Color fundus photograph:
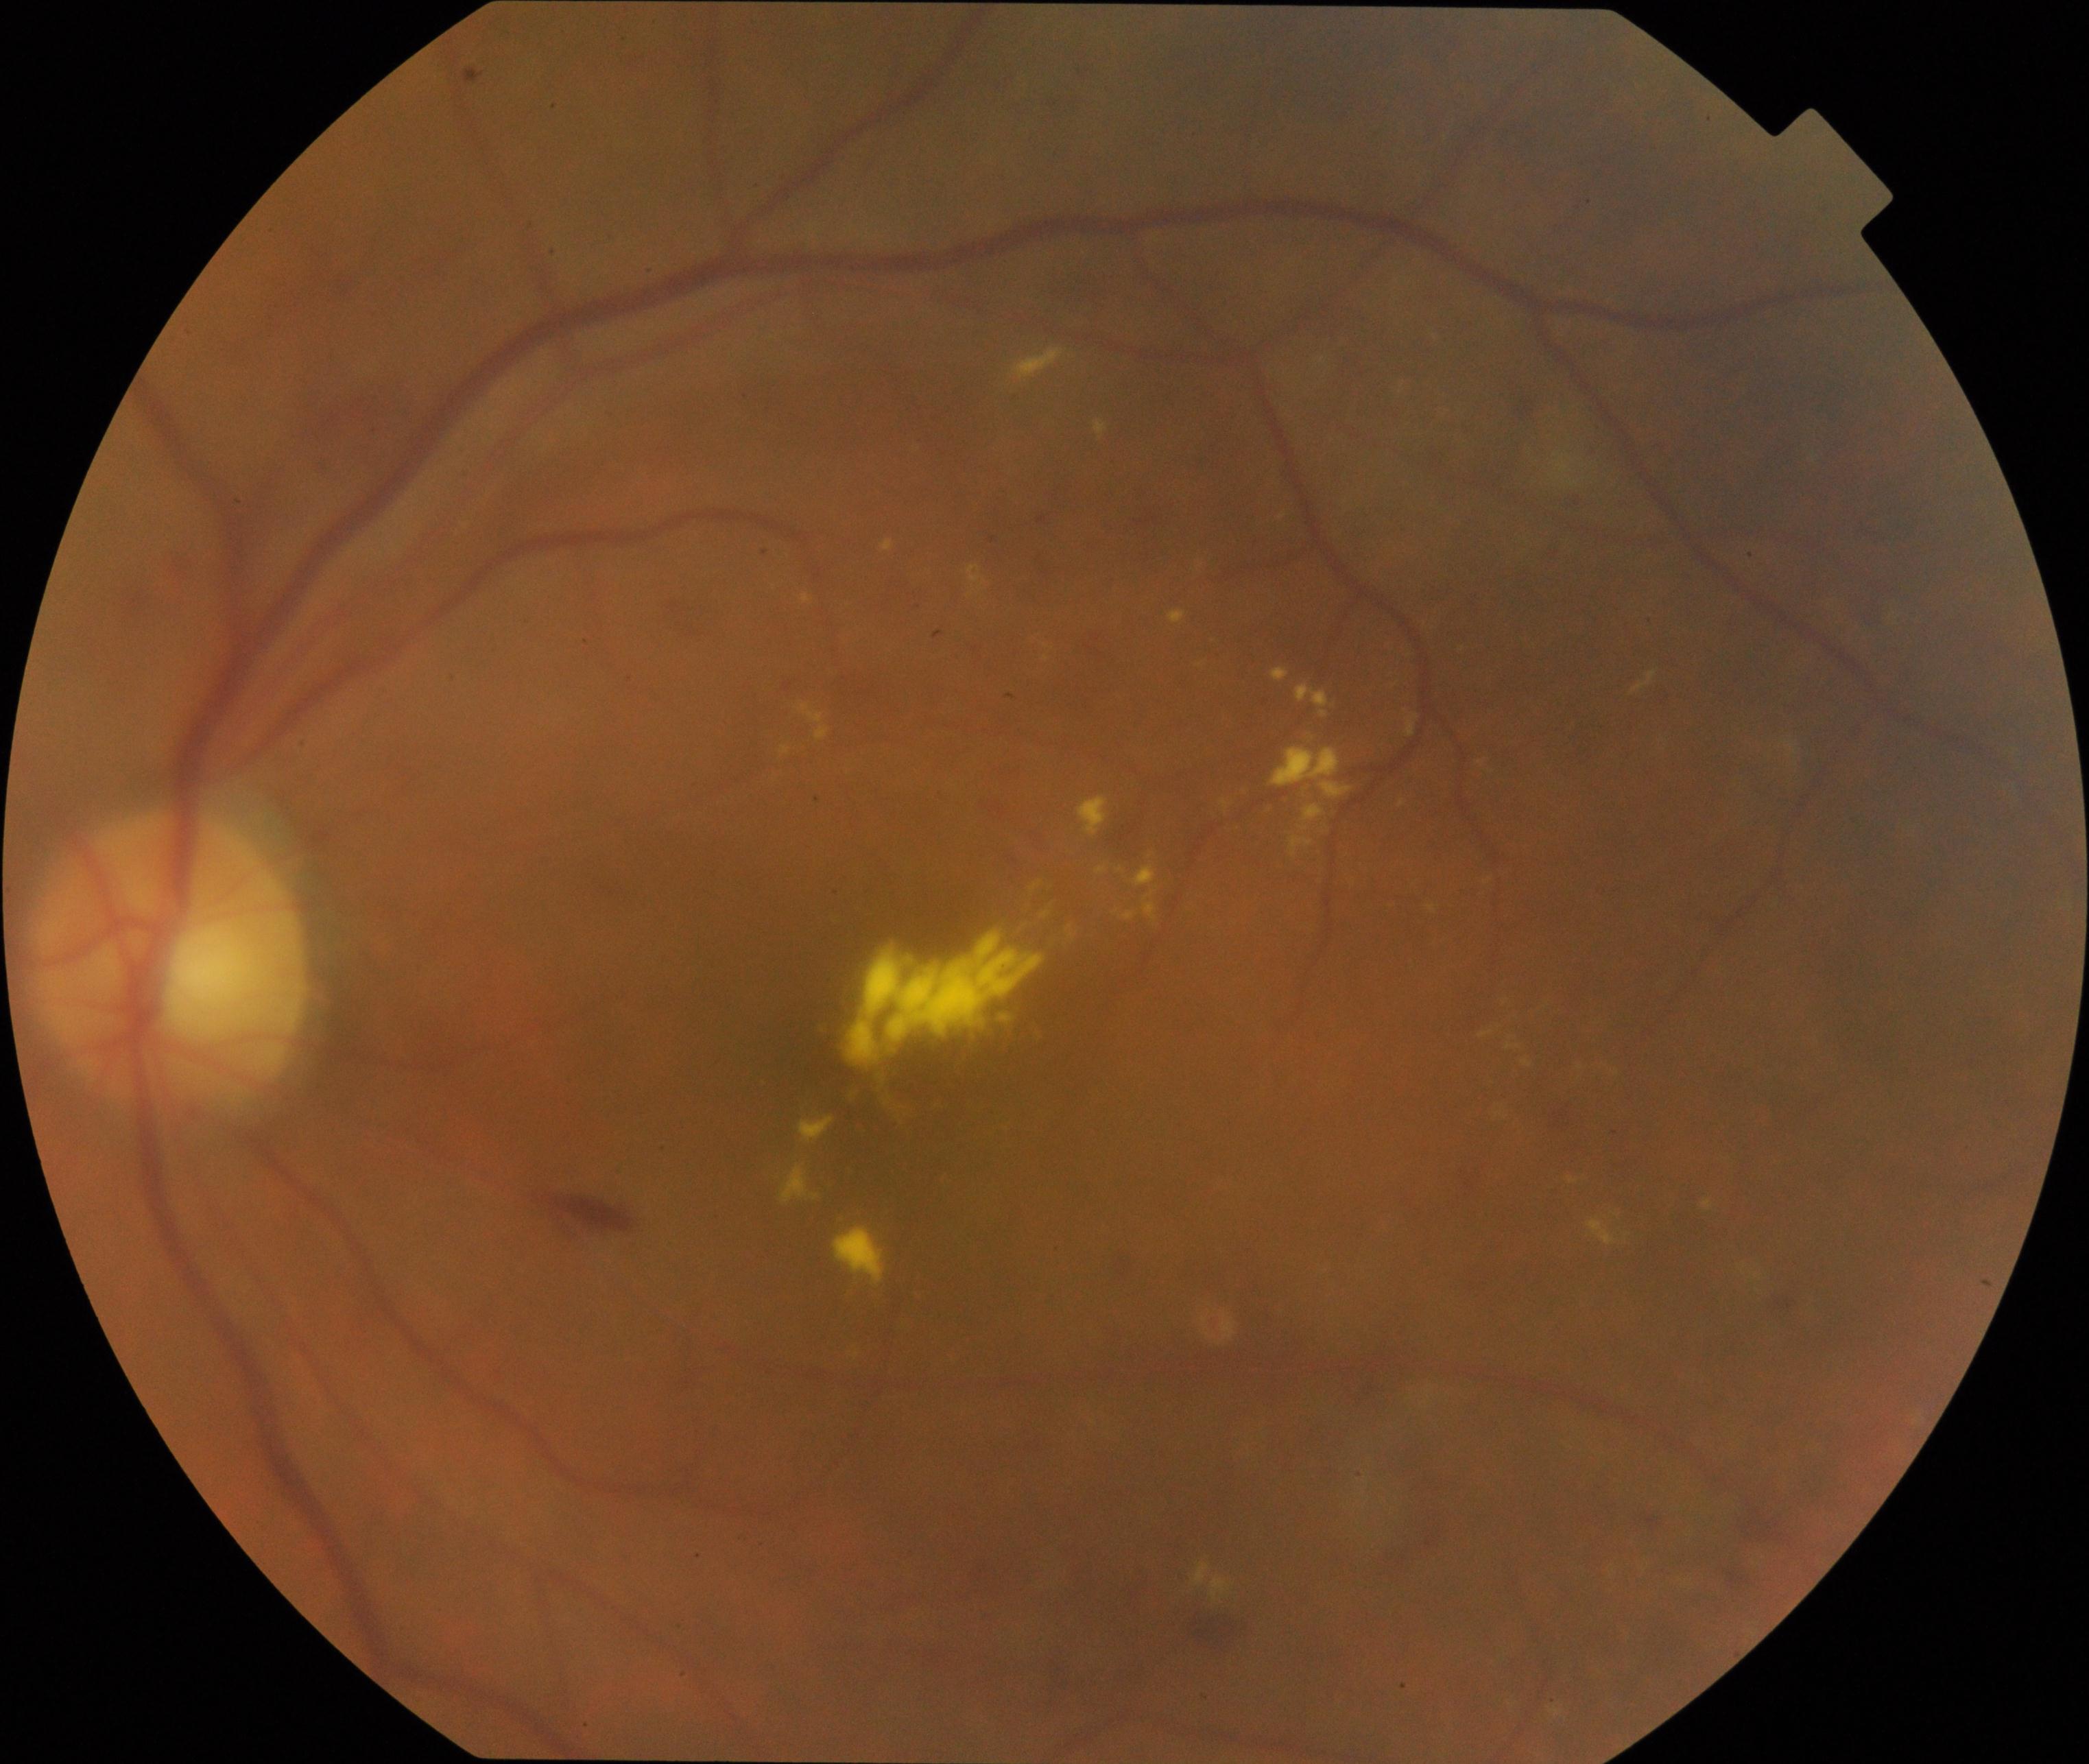 Consistent with moderate non-proliferative diabetic retinopathy.